Image size 240x240; Nidek AFC-330; optic disc-centered crop:
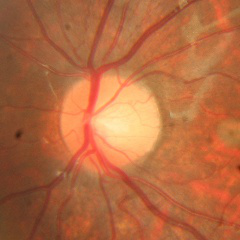 No signs of glaucoma.